Camera: NIDEK AFC-230; 45 degree fundus photograph: 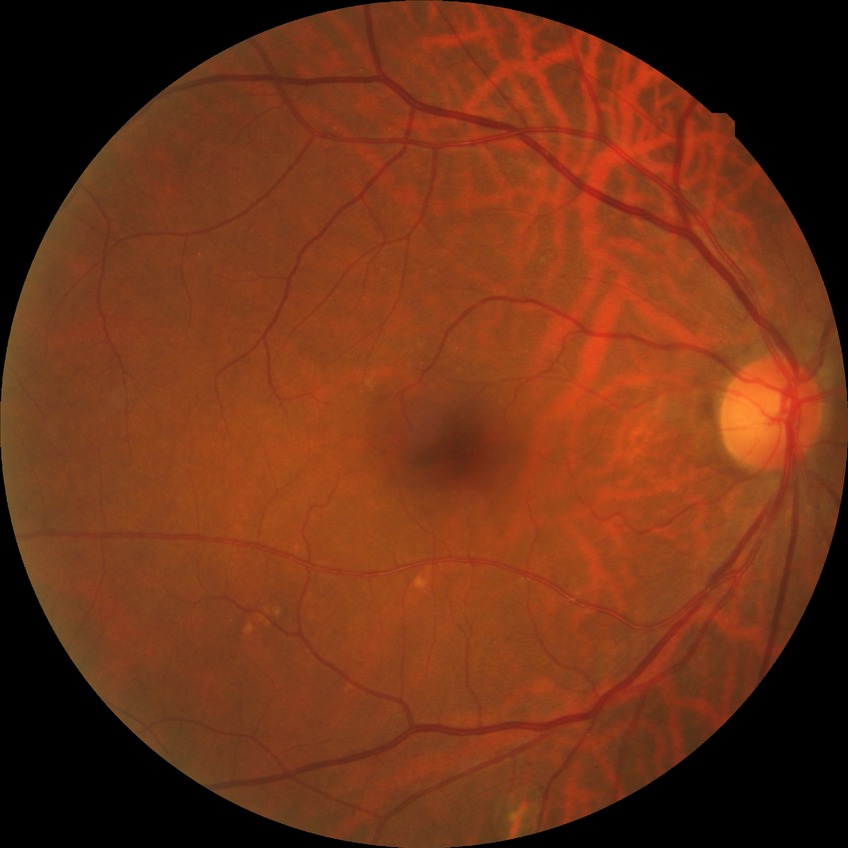

Findings:
– diabetic retinopathy (DR) — no diabetic retinopathy (NDR)